Color fundus image · 45° field of view.
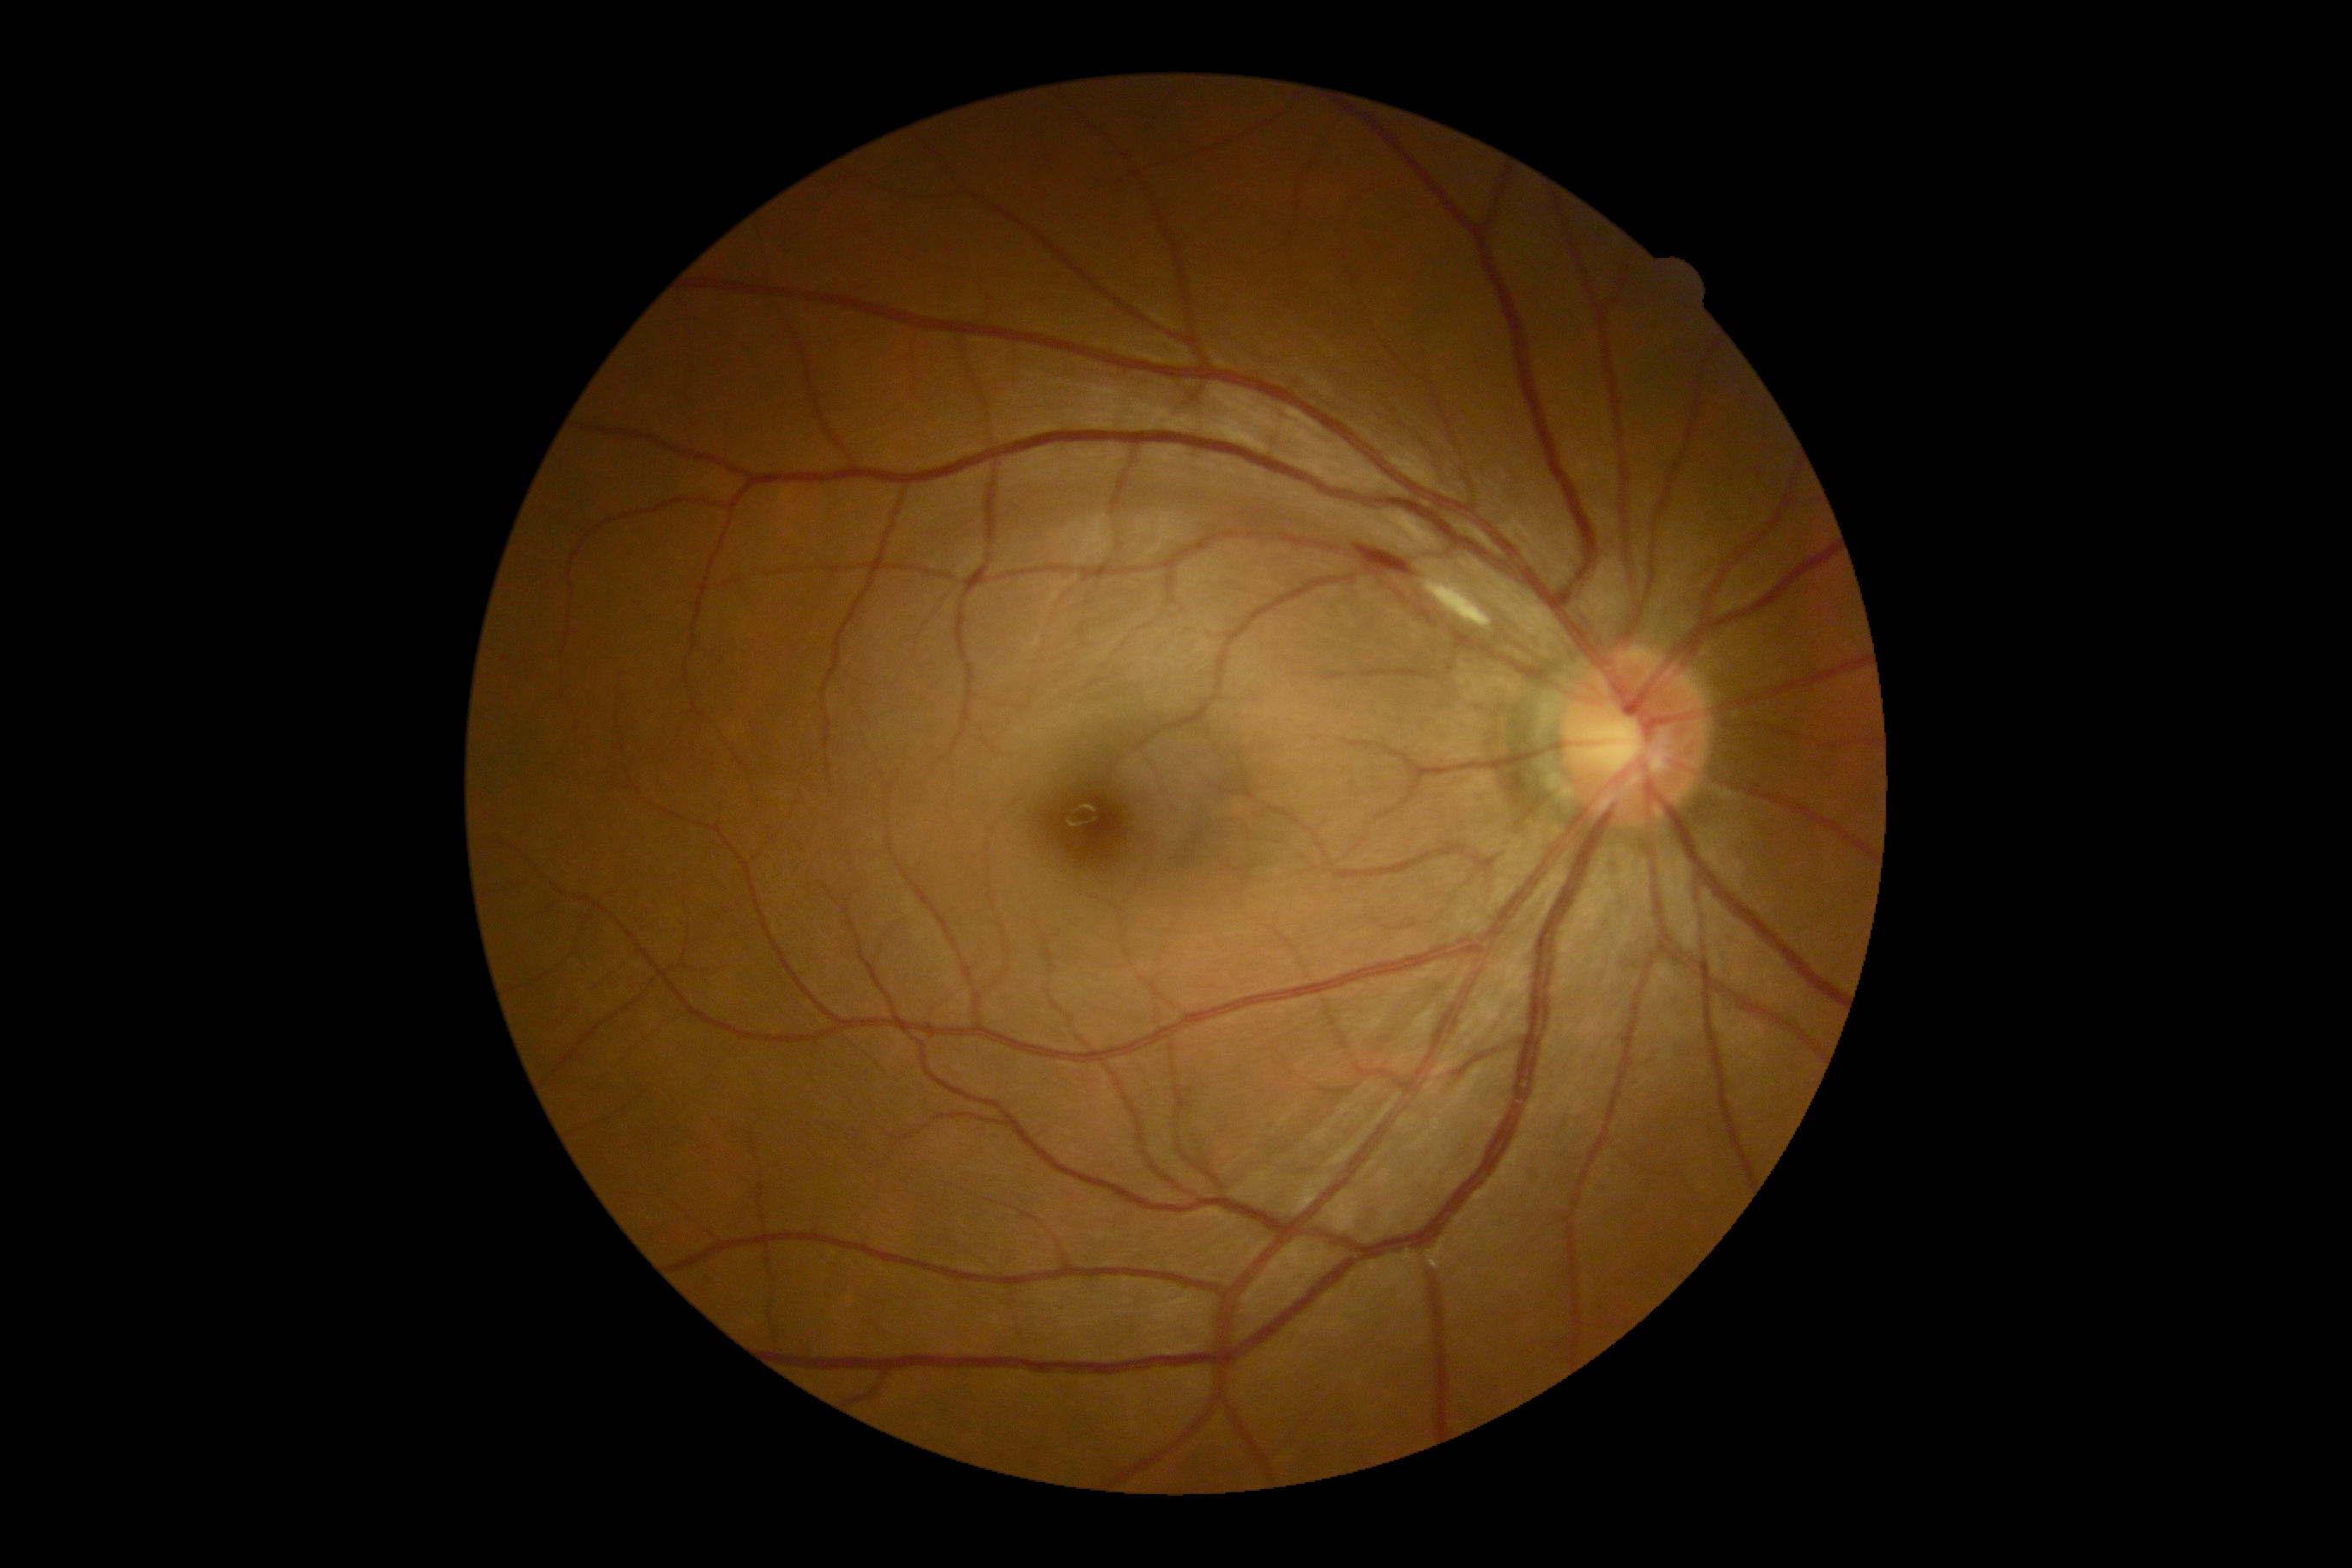

DR stage is moderate NPDR (grade 2).